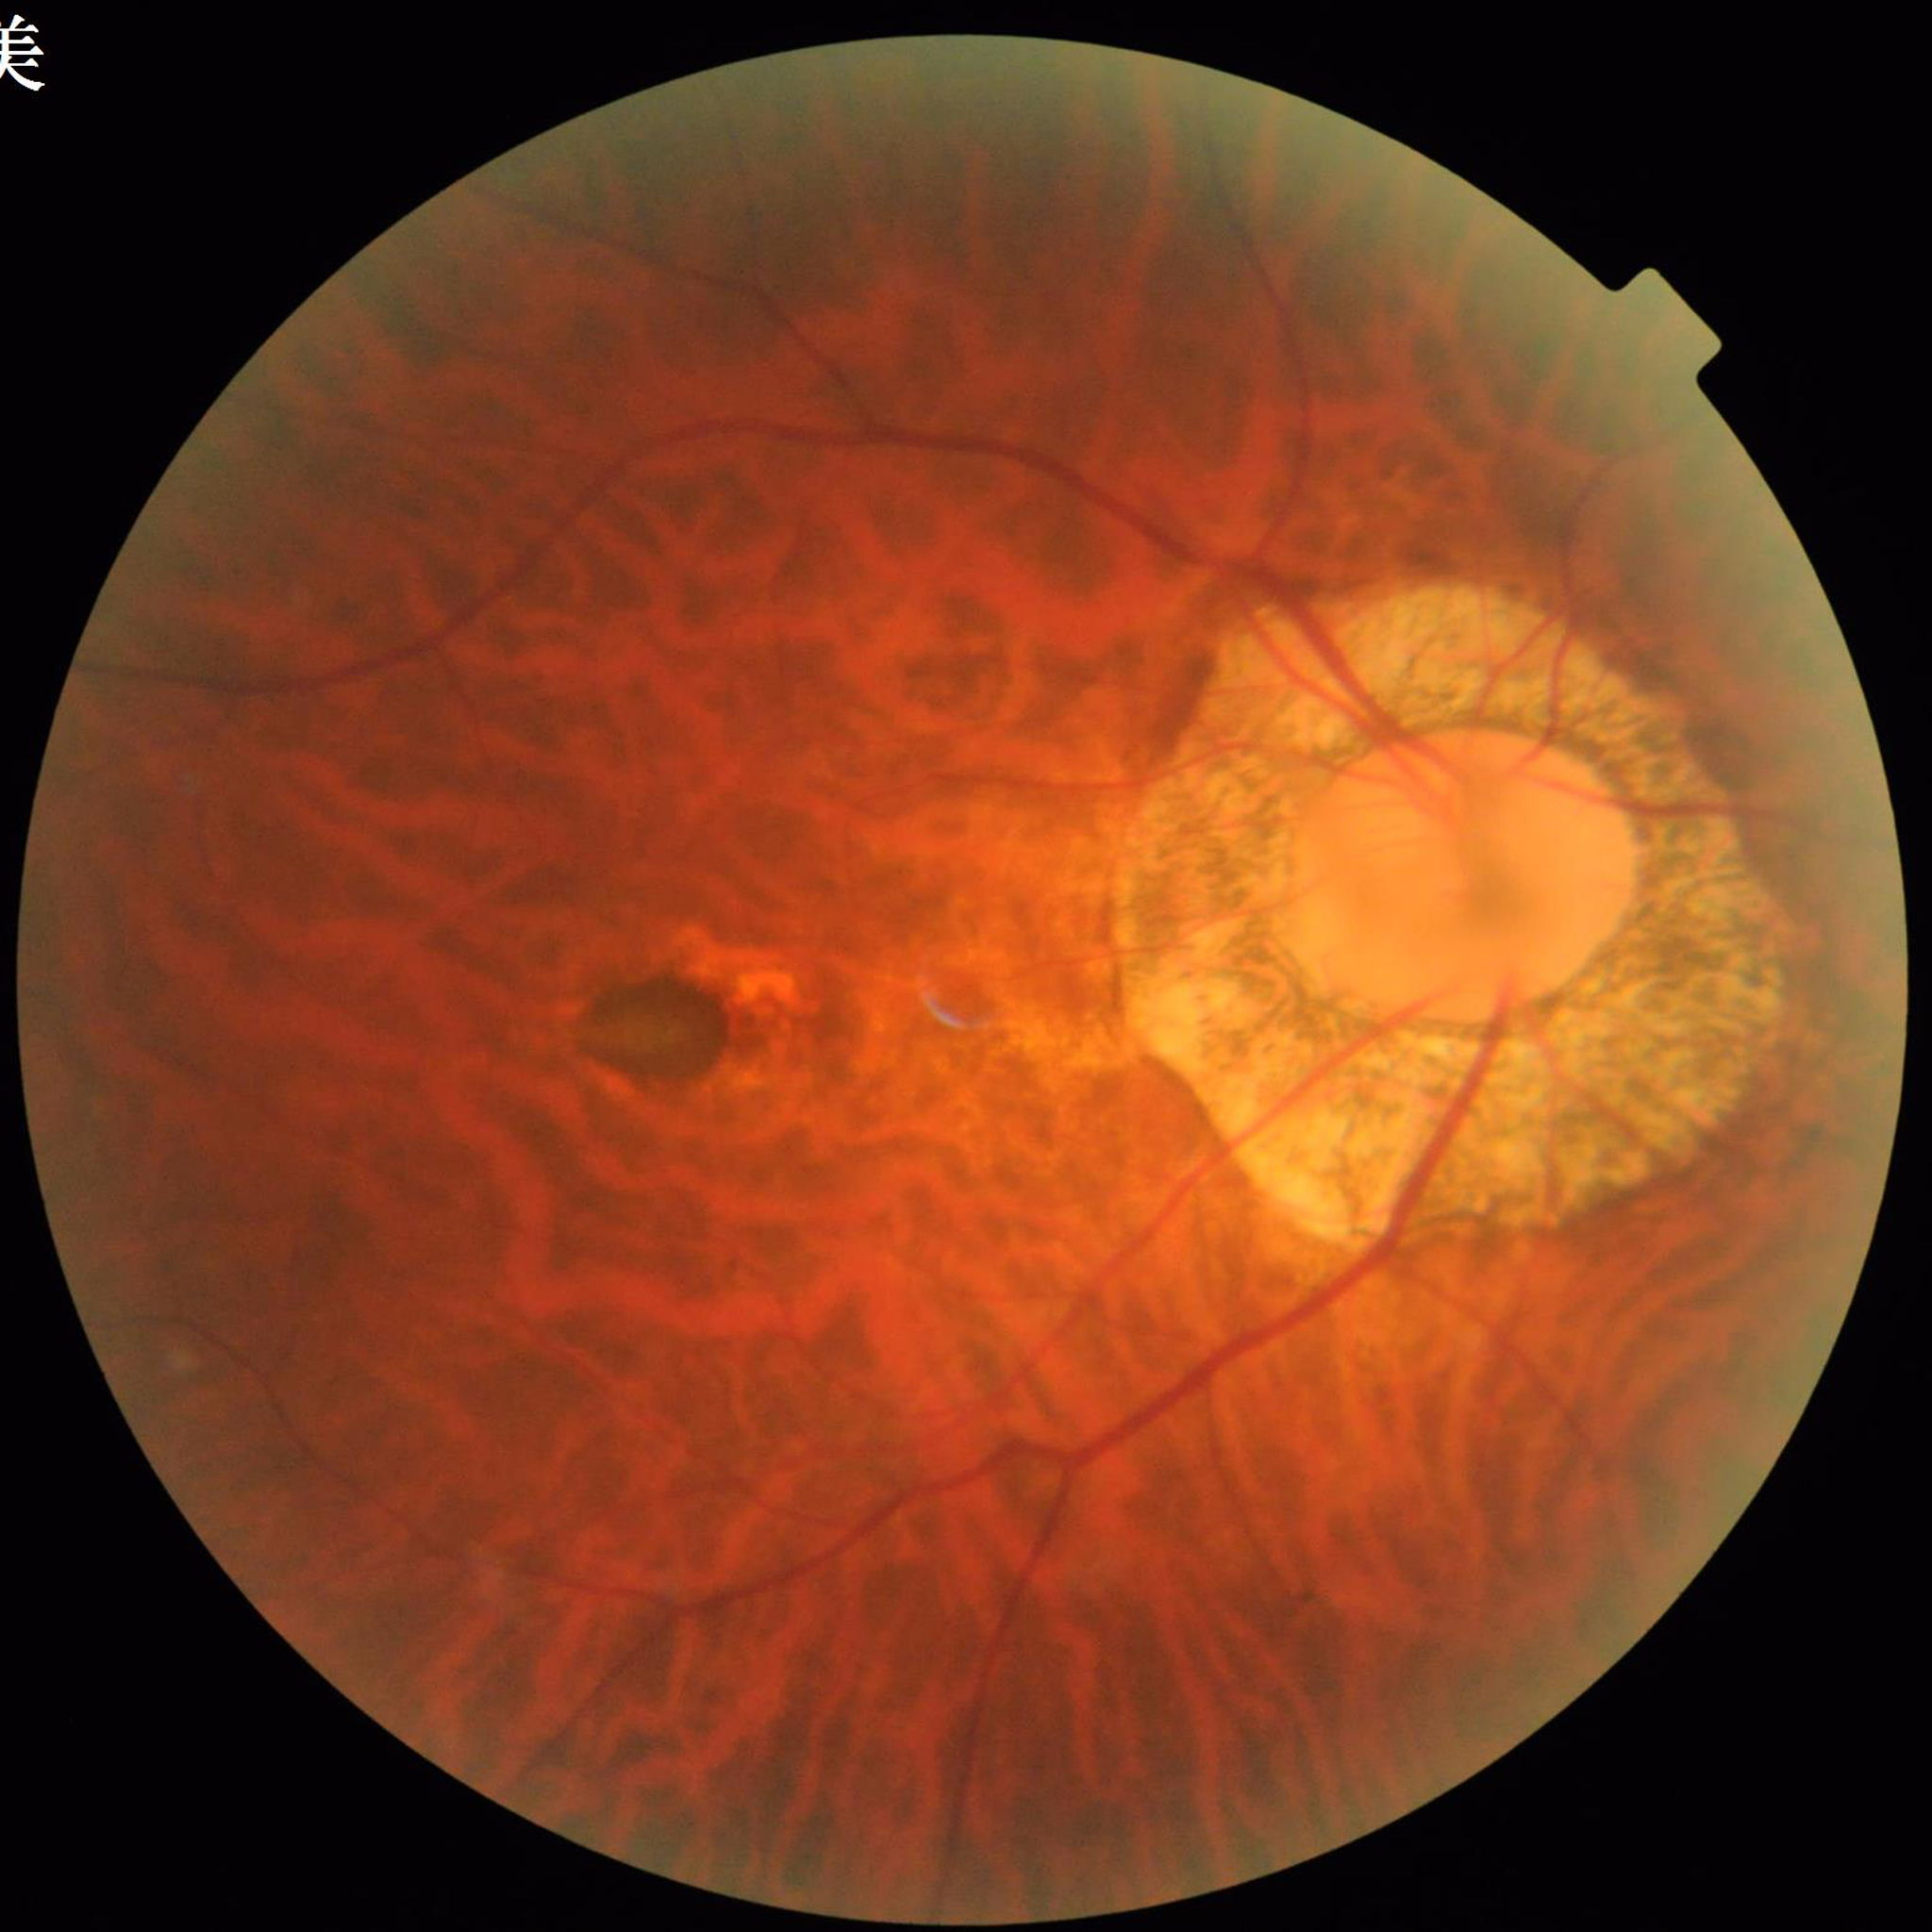 Photo quality: good. Diagnosed with age-related macular degeneration.